Wide-field contact fundus photograph of an infant — 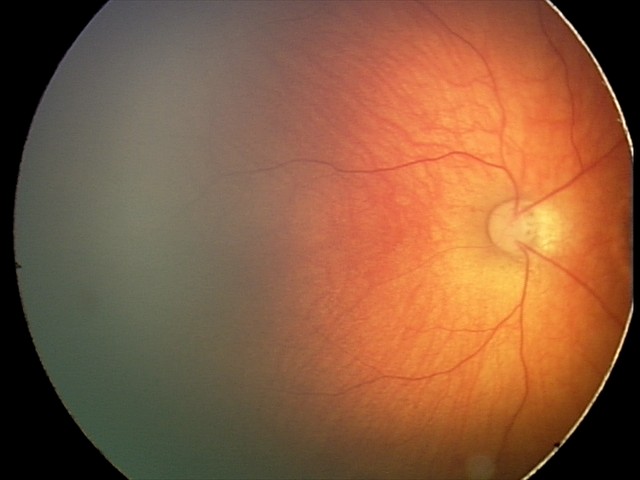
Series diagnosed as toxoplasmosis chorioretinitis.